Posterior pole photograph — 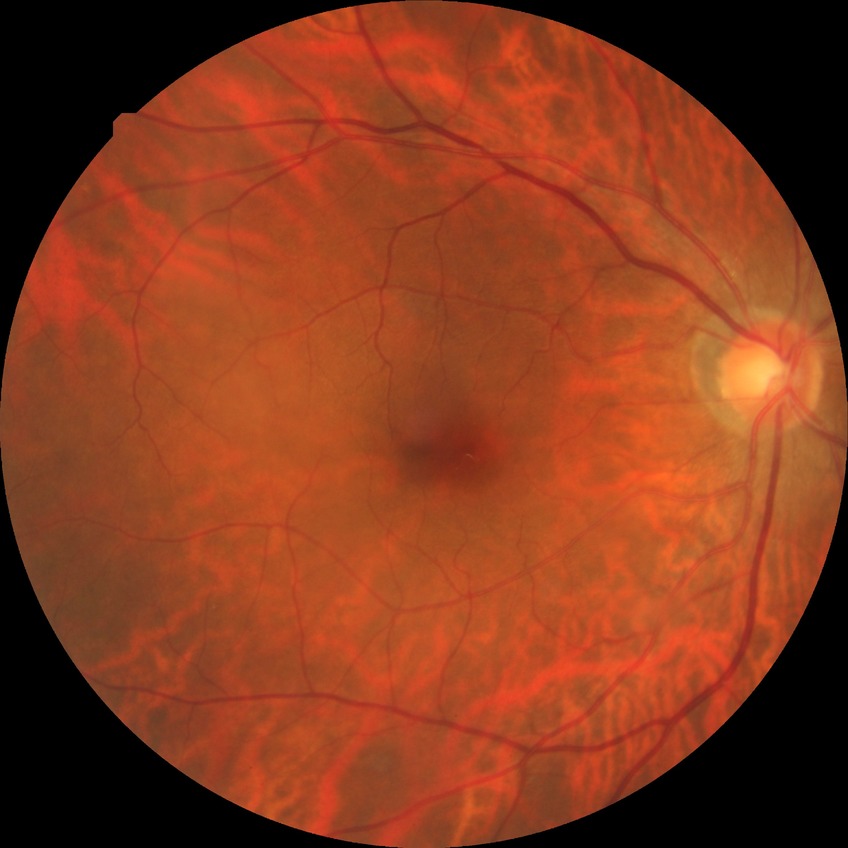

Annotations:
• diabetic retinopathy grade — no diabetic retinopathy